Color fundus photograph:
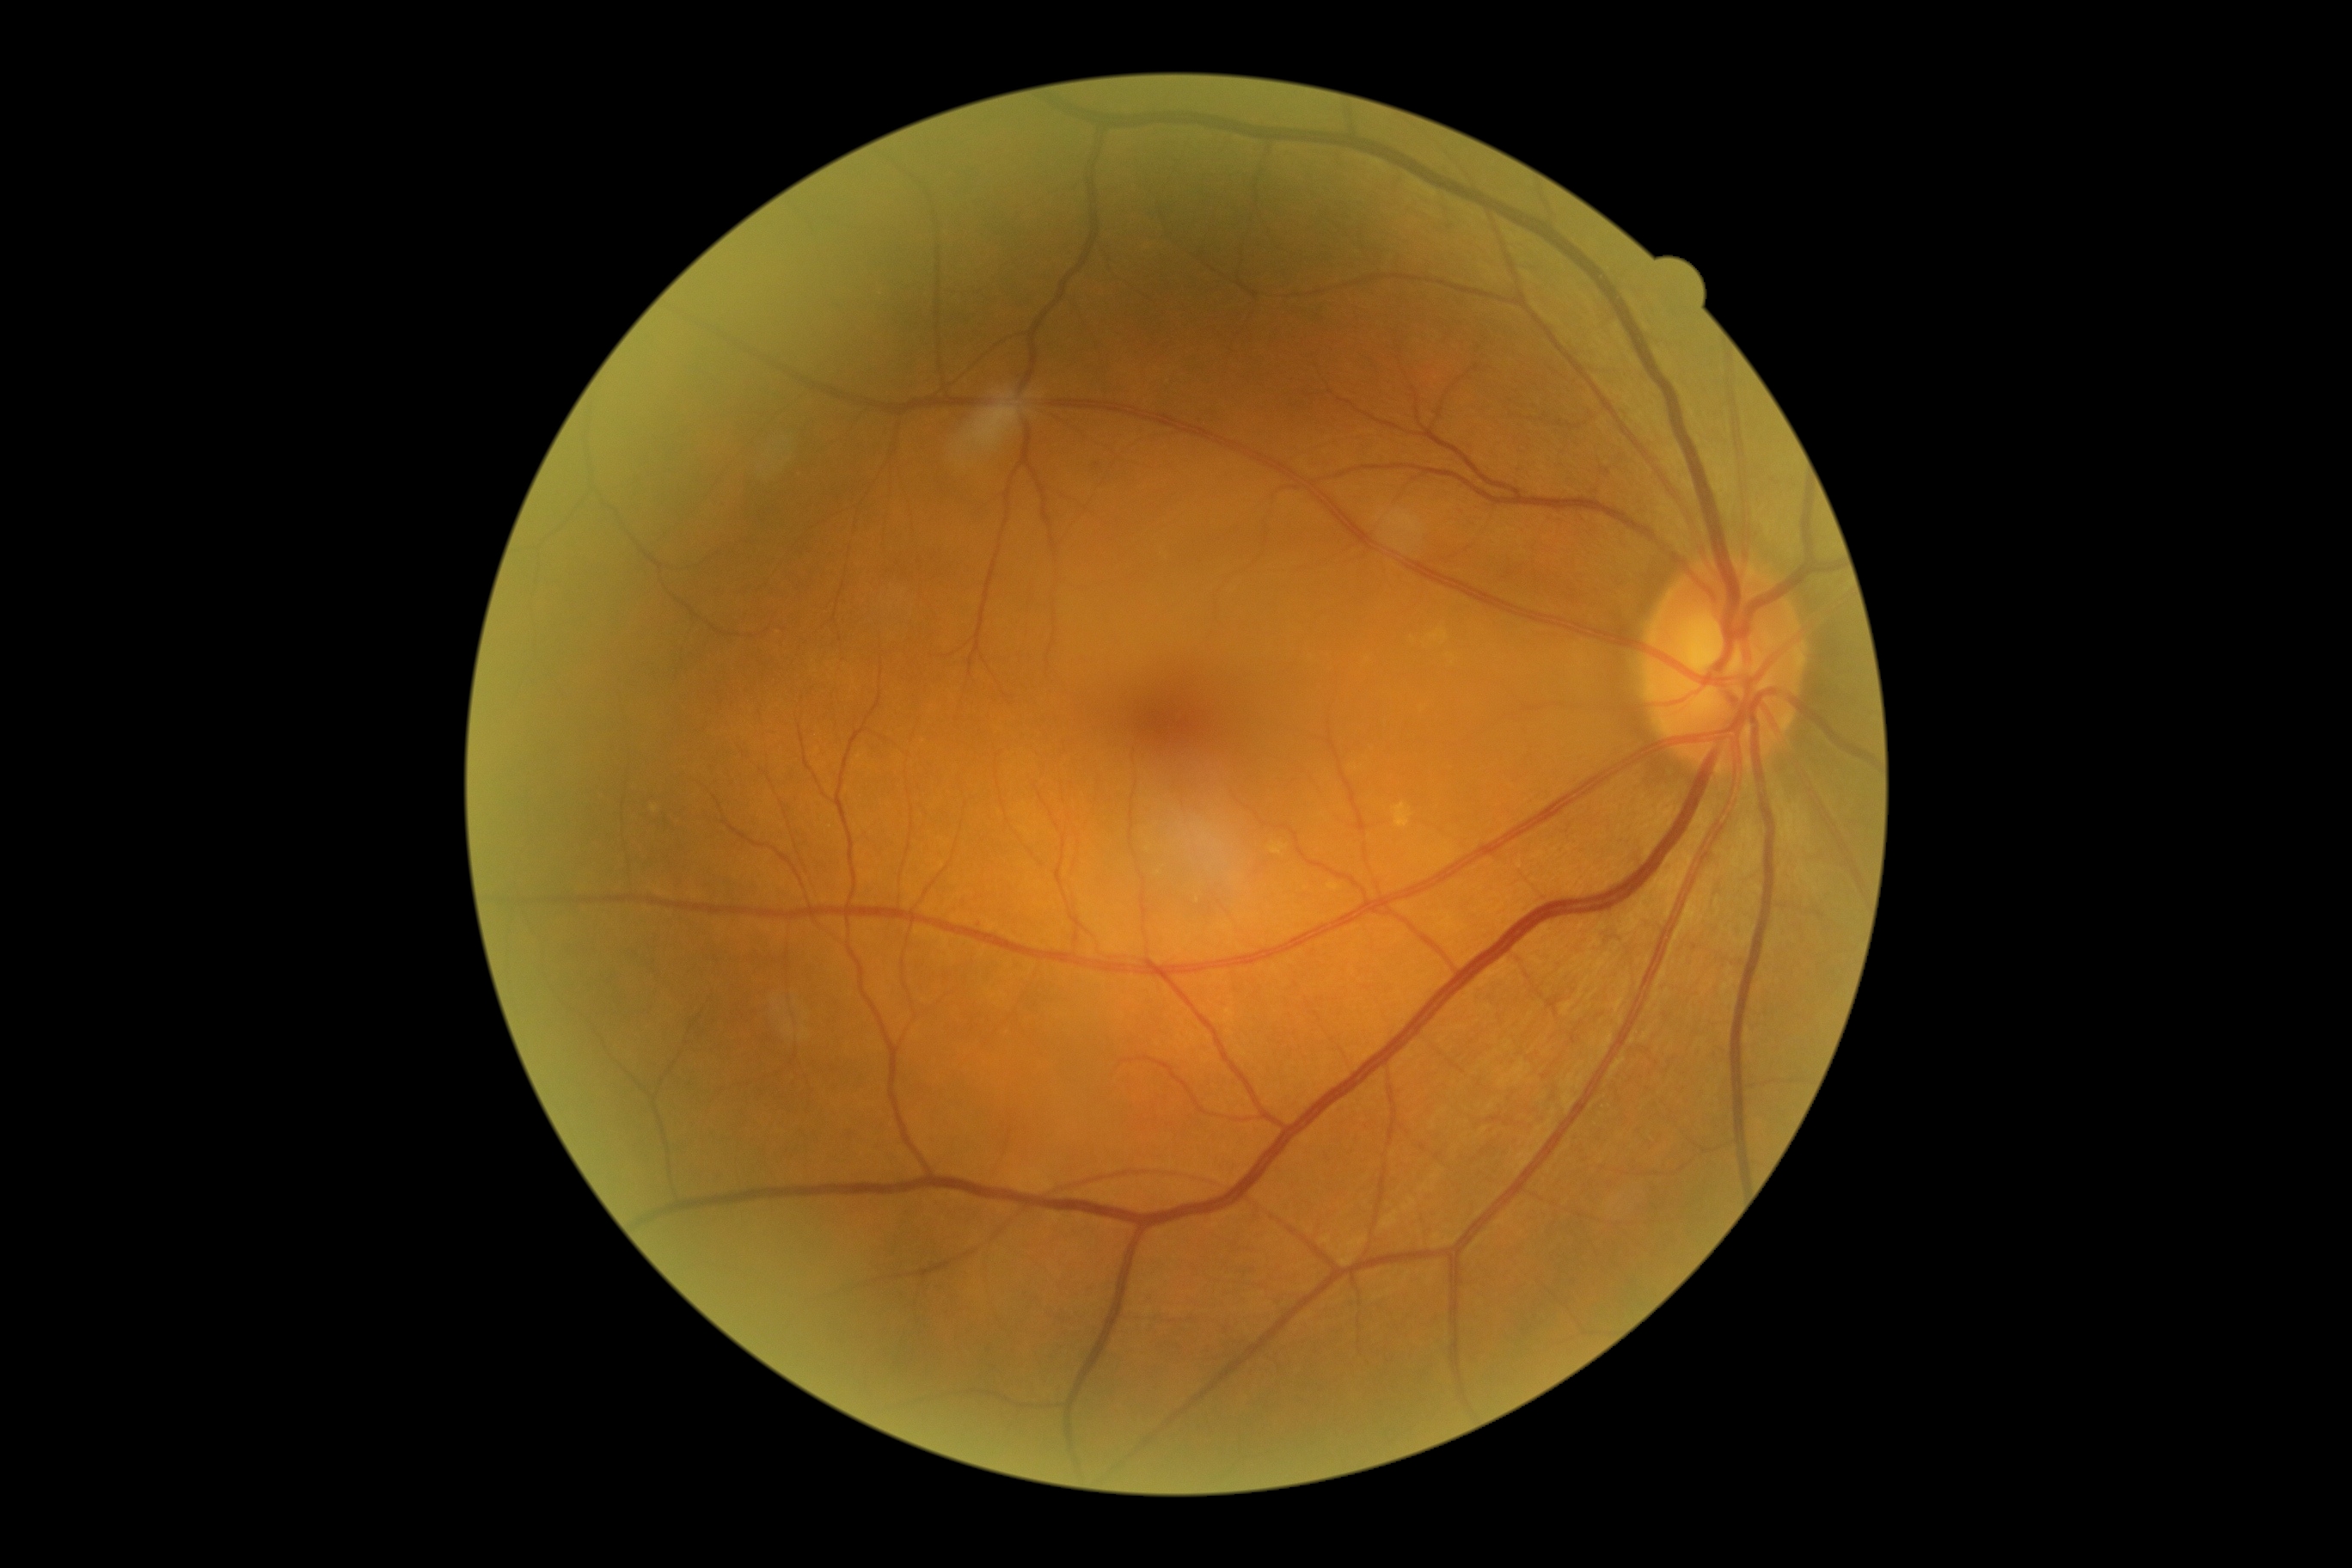 - diabetic retinopathy grade — 0